Graded on the modified Davis scale.
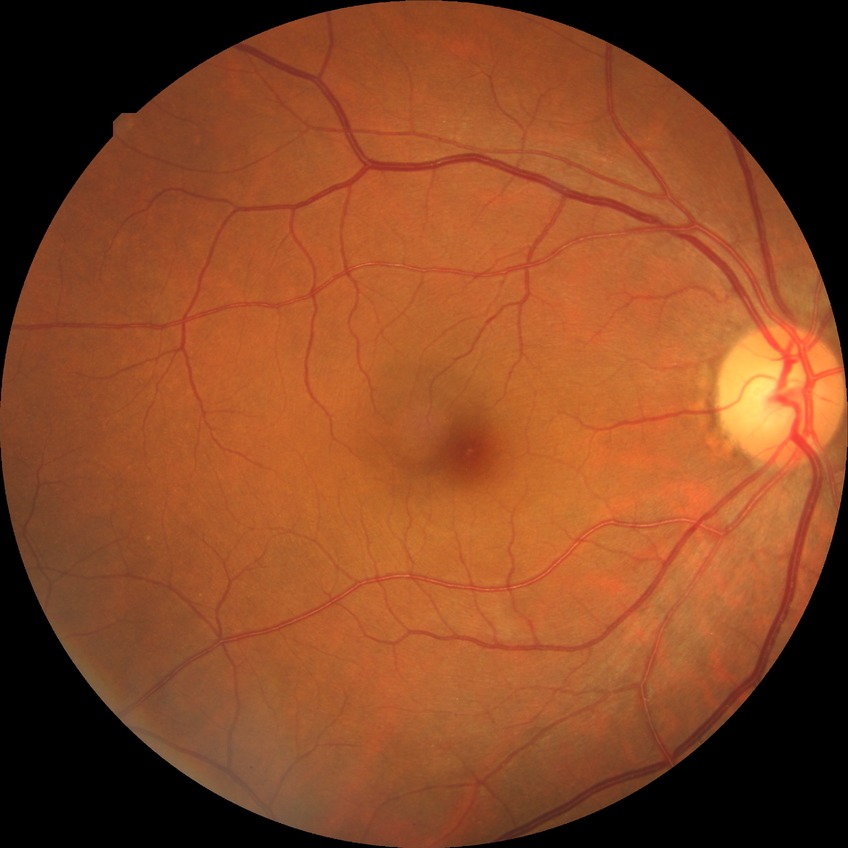 {"davis_grade": "NDR (no diabetic retinopathy)"}